2346 by 1568 pixels: 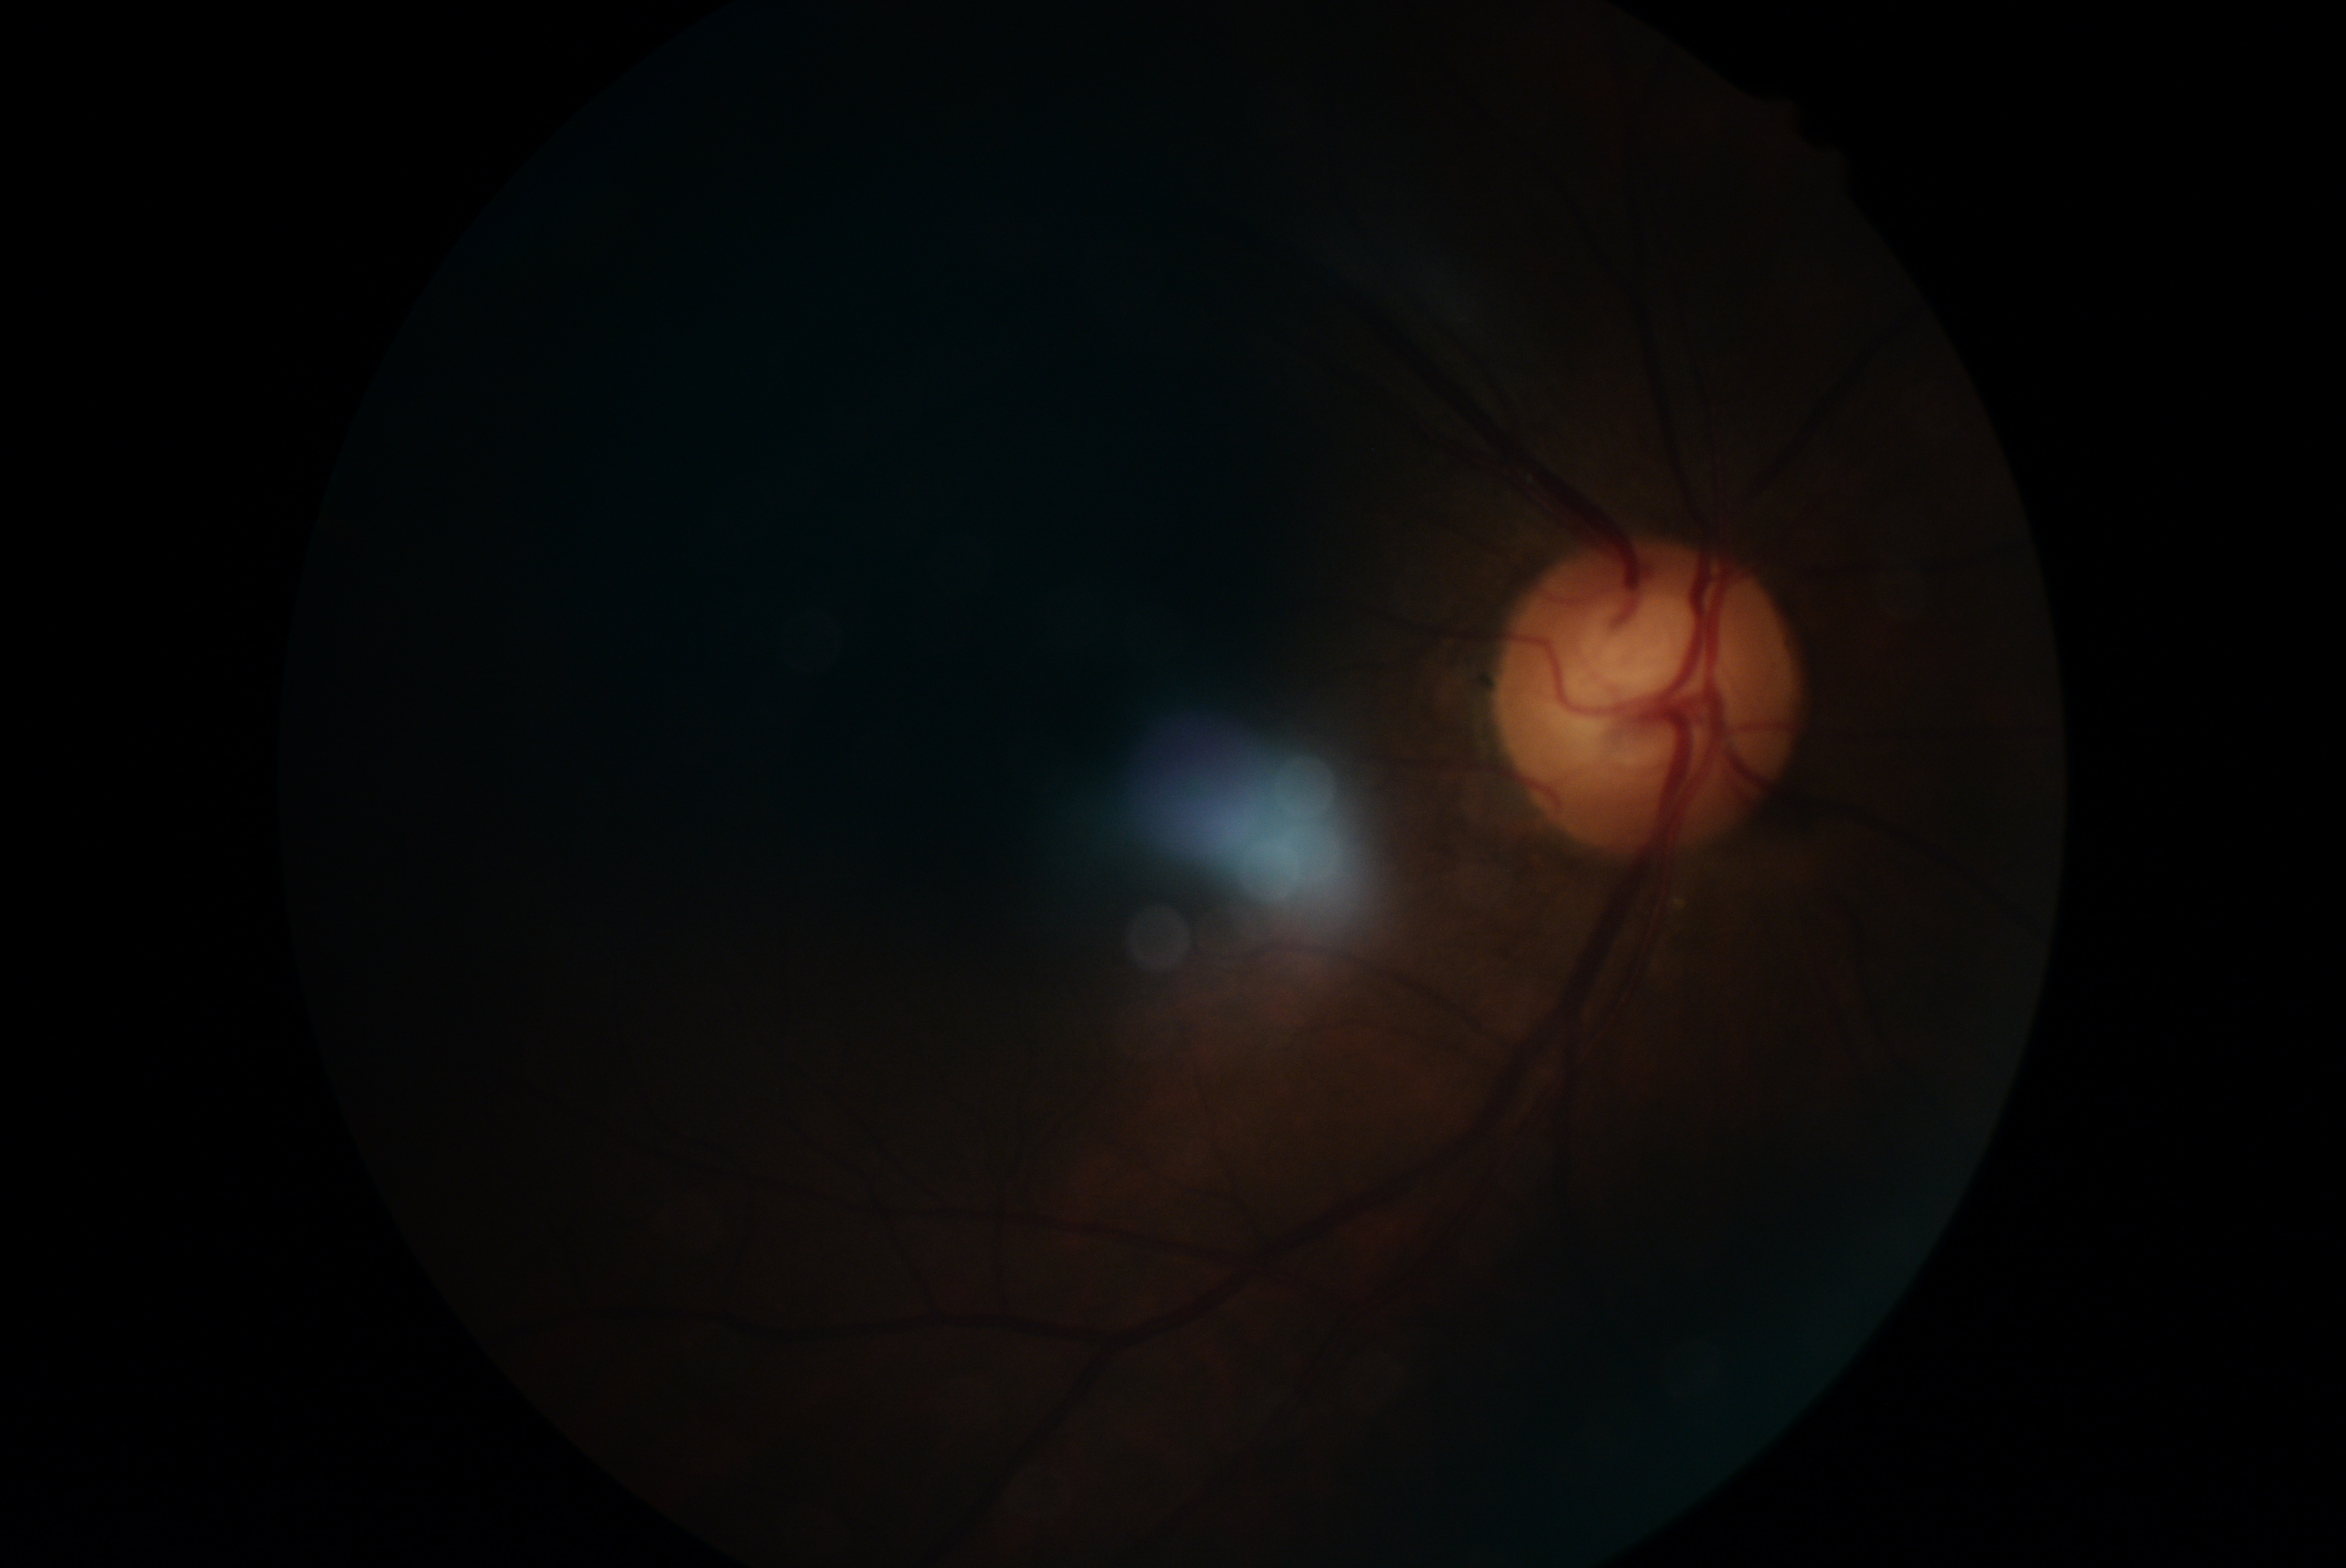

Diabetic retinopathy (DR): ungradable.